45-degree field of view: 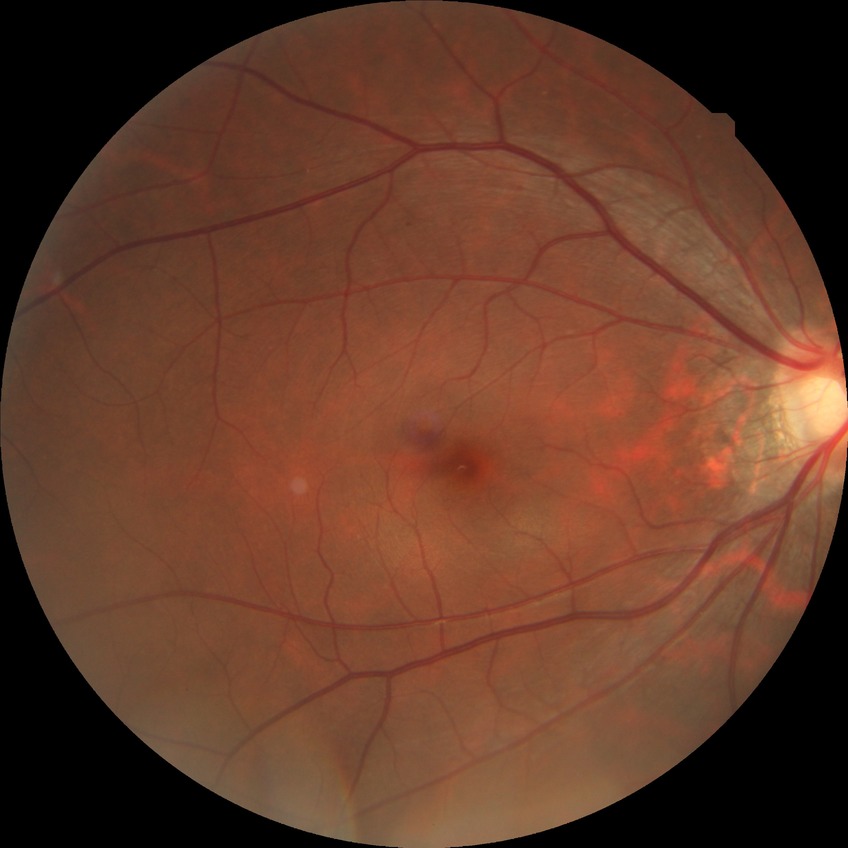

DR class: non-proliferative diabetic retinopathy. Diabetic retinopathy (DR) is simple diabetic retinopathy (SDR).